848x848px, posterior pole photograph.
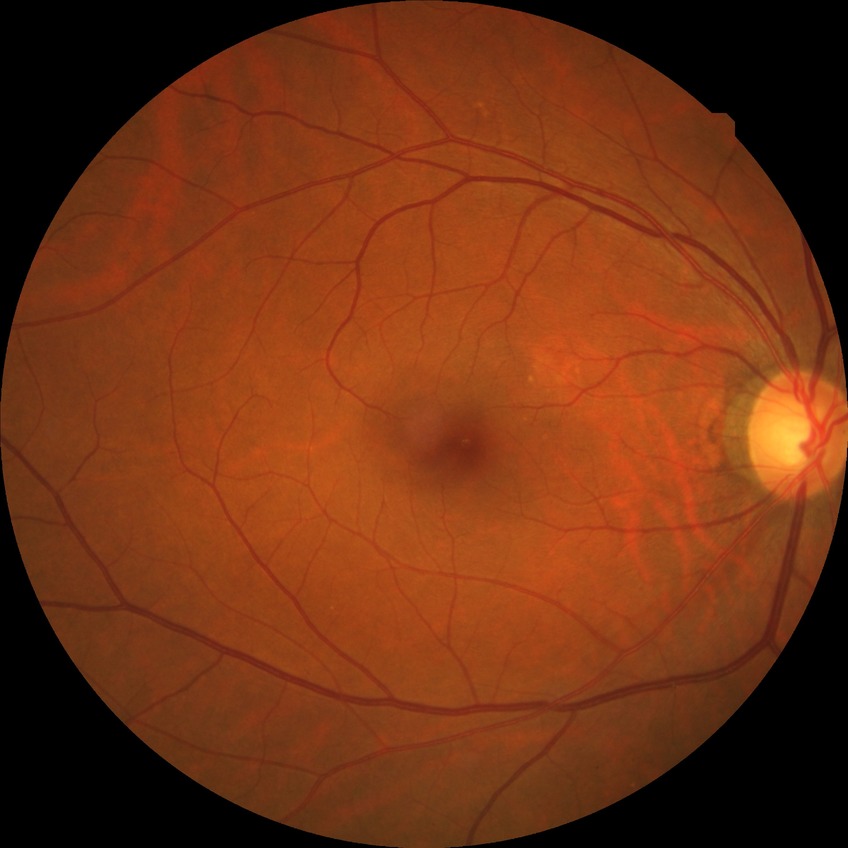
Davis grading is no diabetic retinopathy.